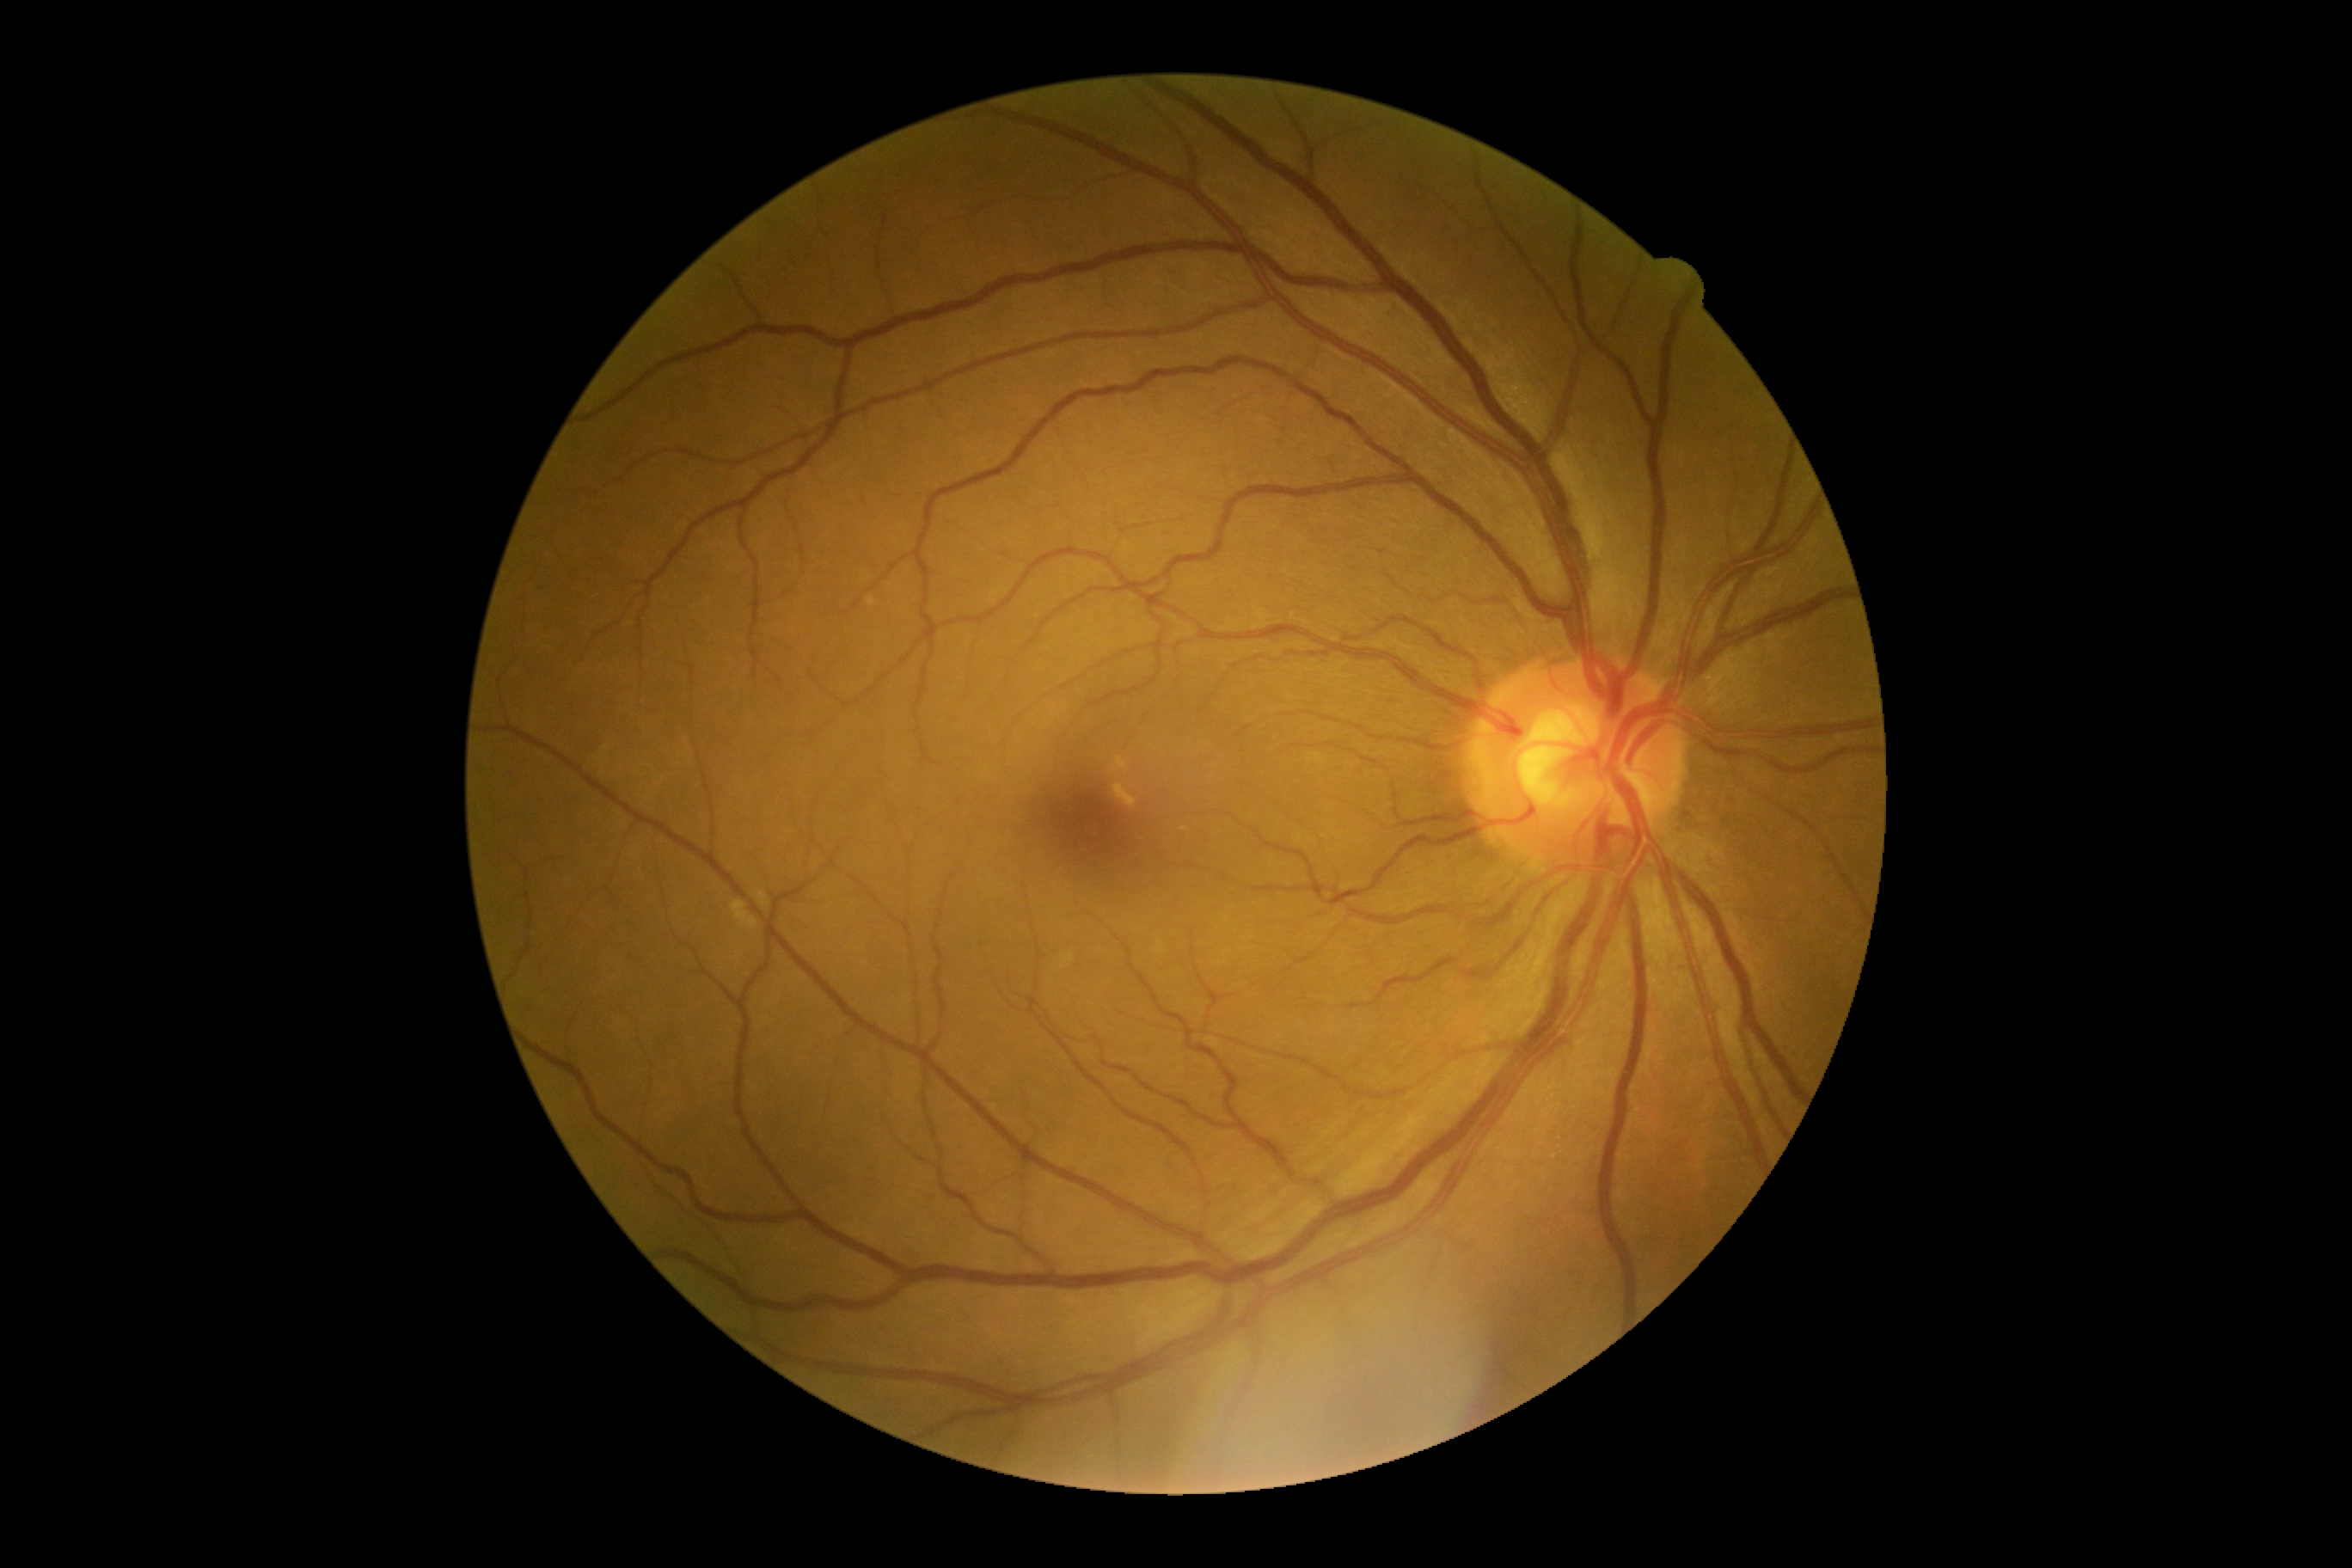 DR stage: 0/4. No DR findings.